Wide-field fundus image from infant ROP screening:
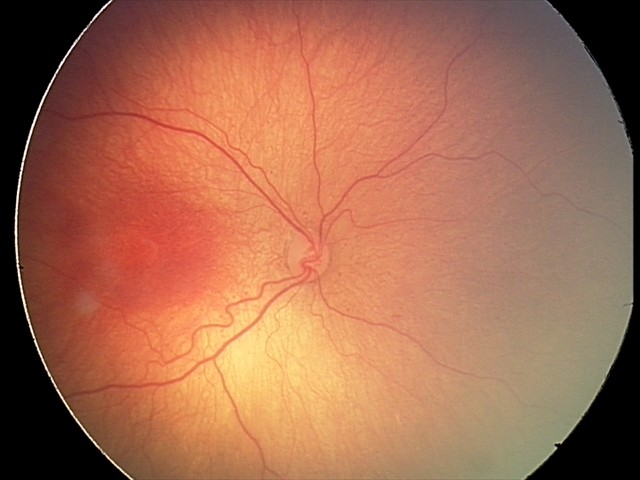

Diagnosis from this screening exam: retinopathy of prematurity (ROP) stage 2 — ridge with height and width at the demarcation line.
Plus disease absent.